FOV: 50 degrees · 2228x1652
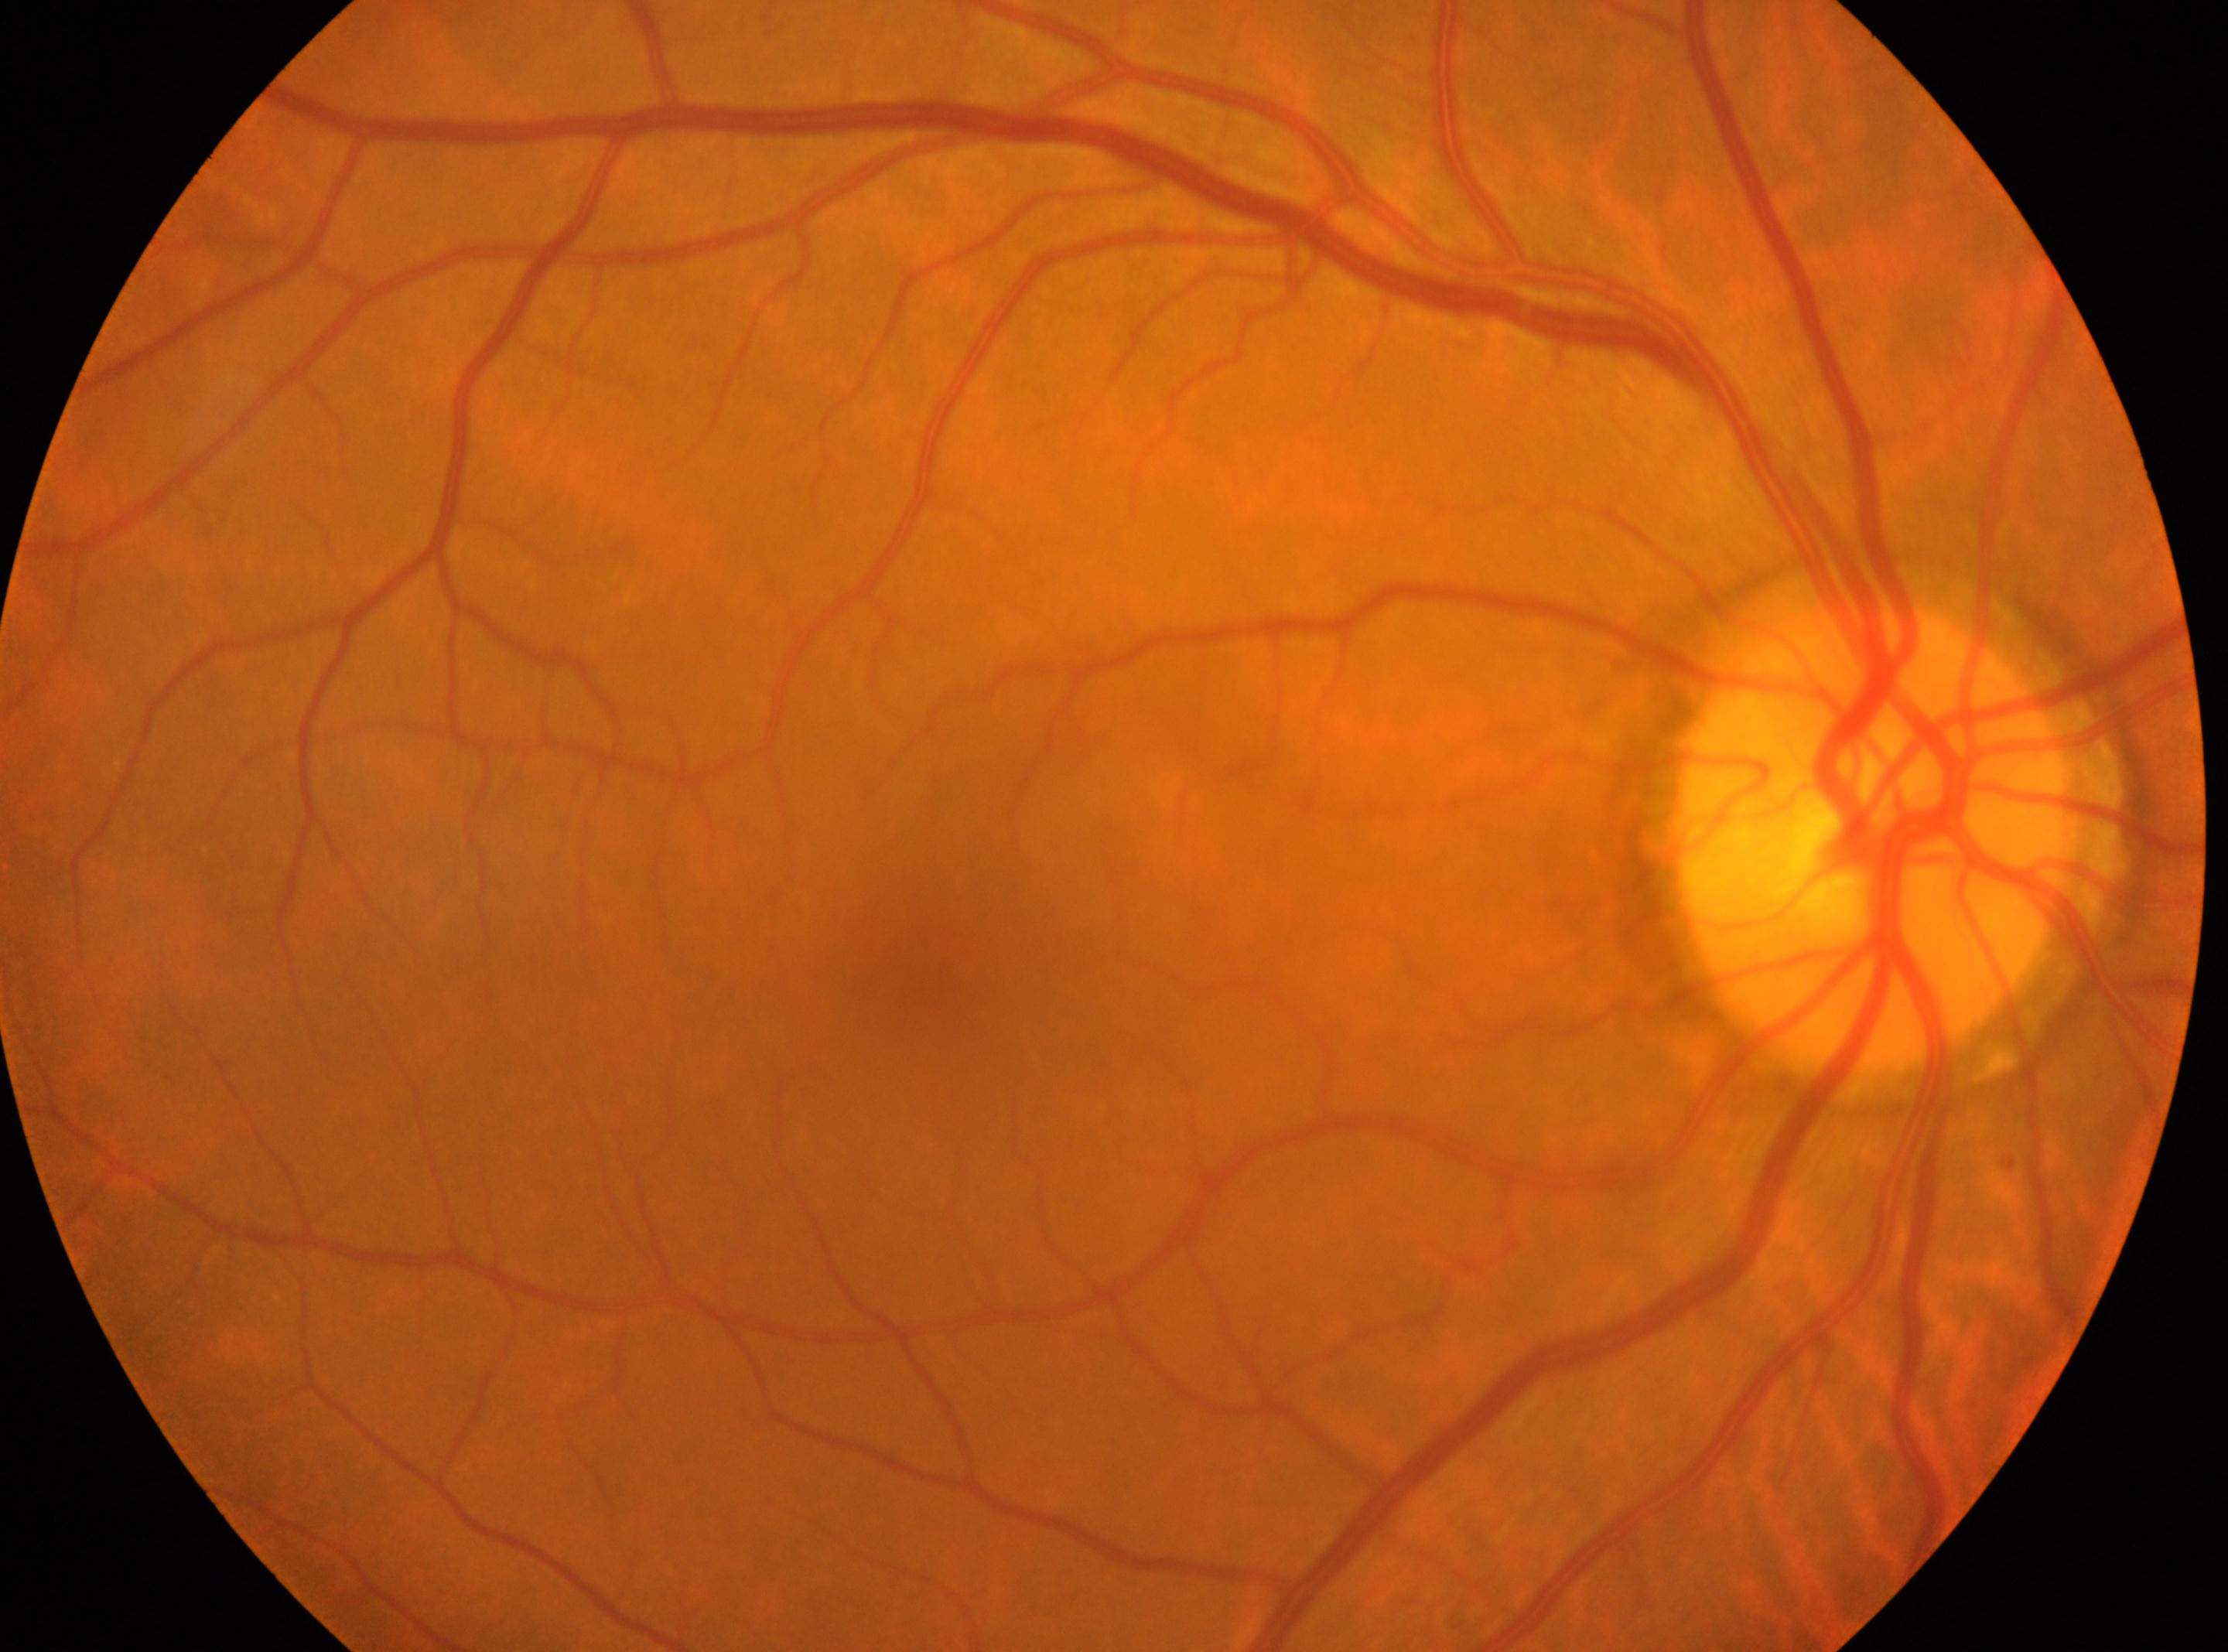

| feature | annotation |
|---|---|
| macula center | (x: 916, y: 976) |
| laterality | right eye |
| DR stage | grade 0 (no apparent retinopathy) |
| optic nerve head | (x: 1870, y: 842) |